Color fundus photograph.
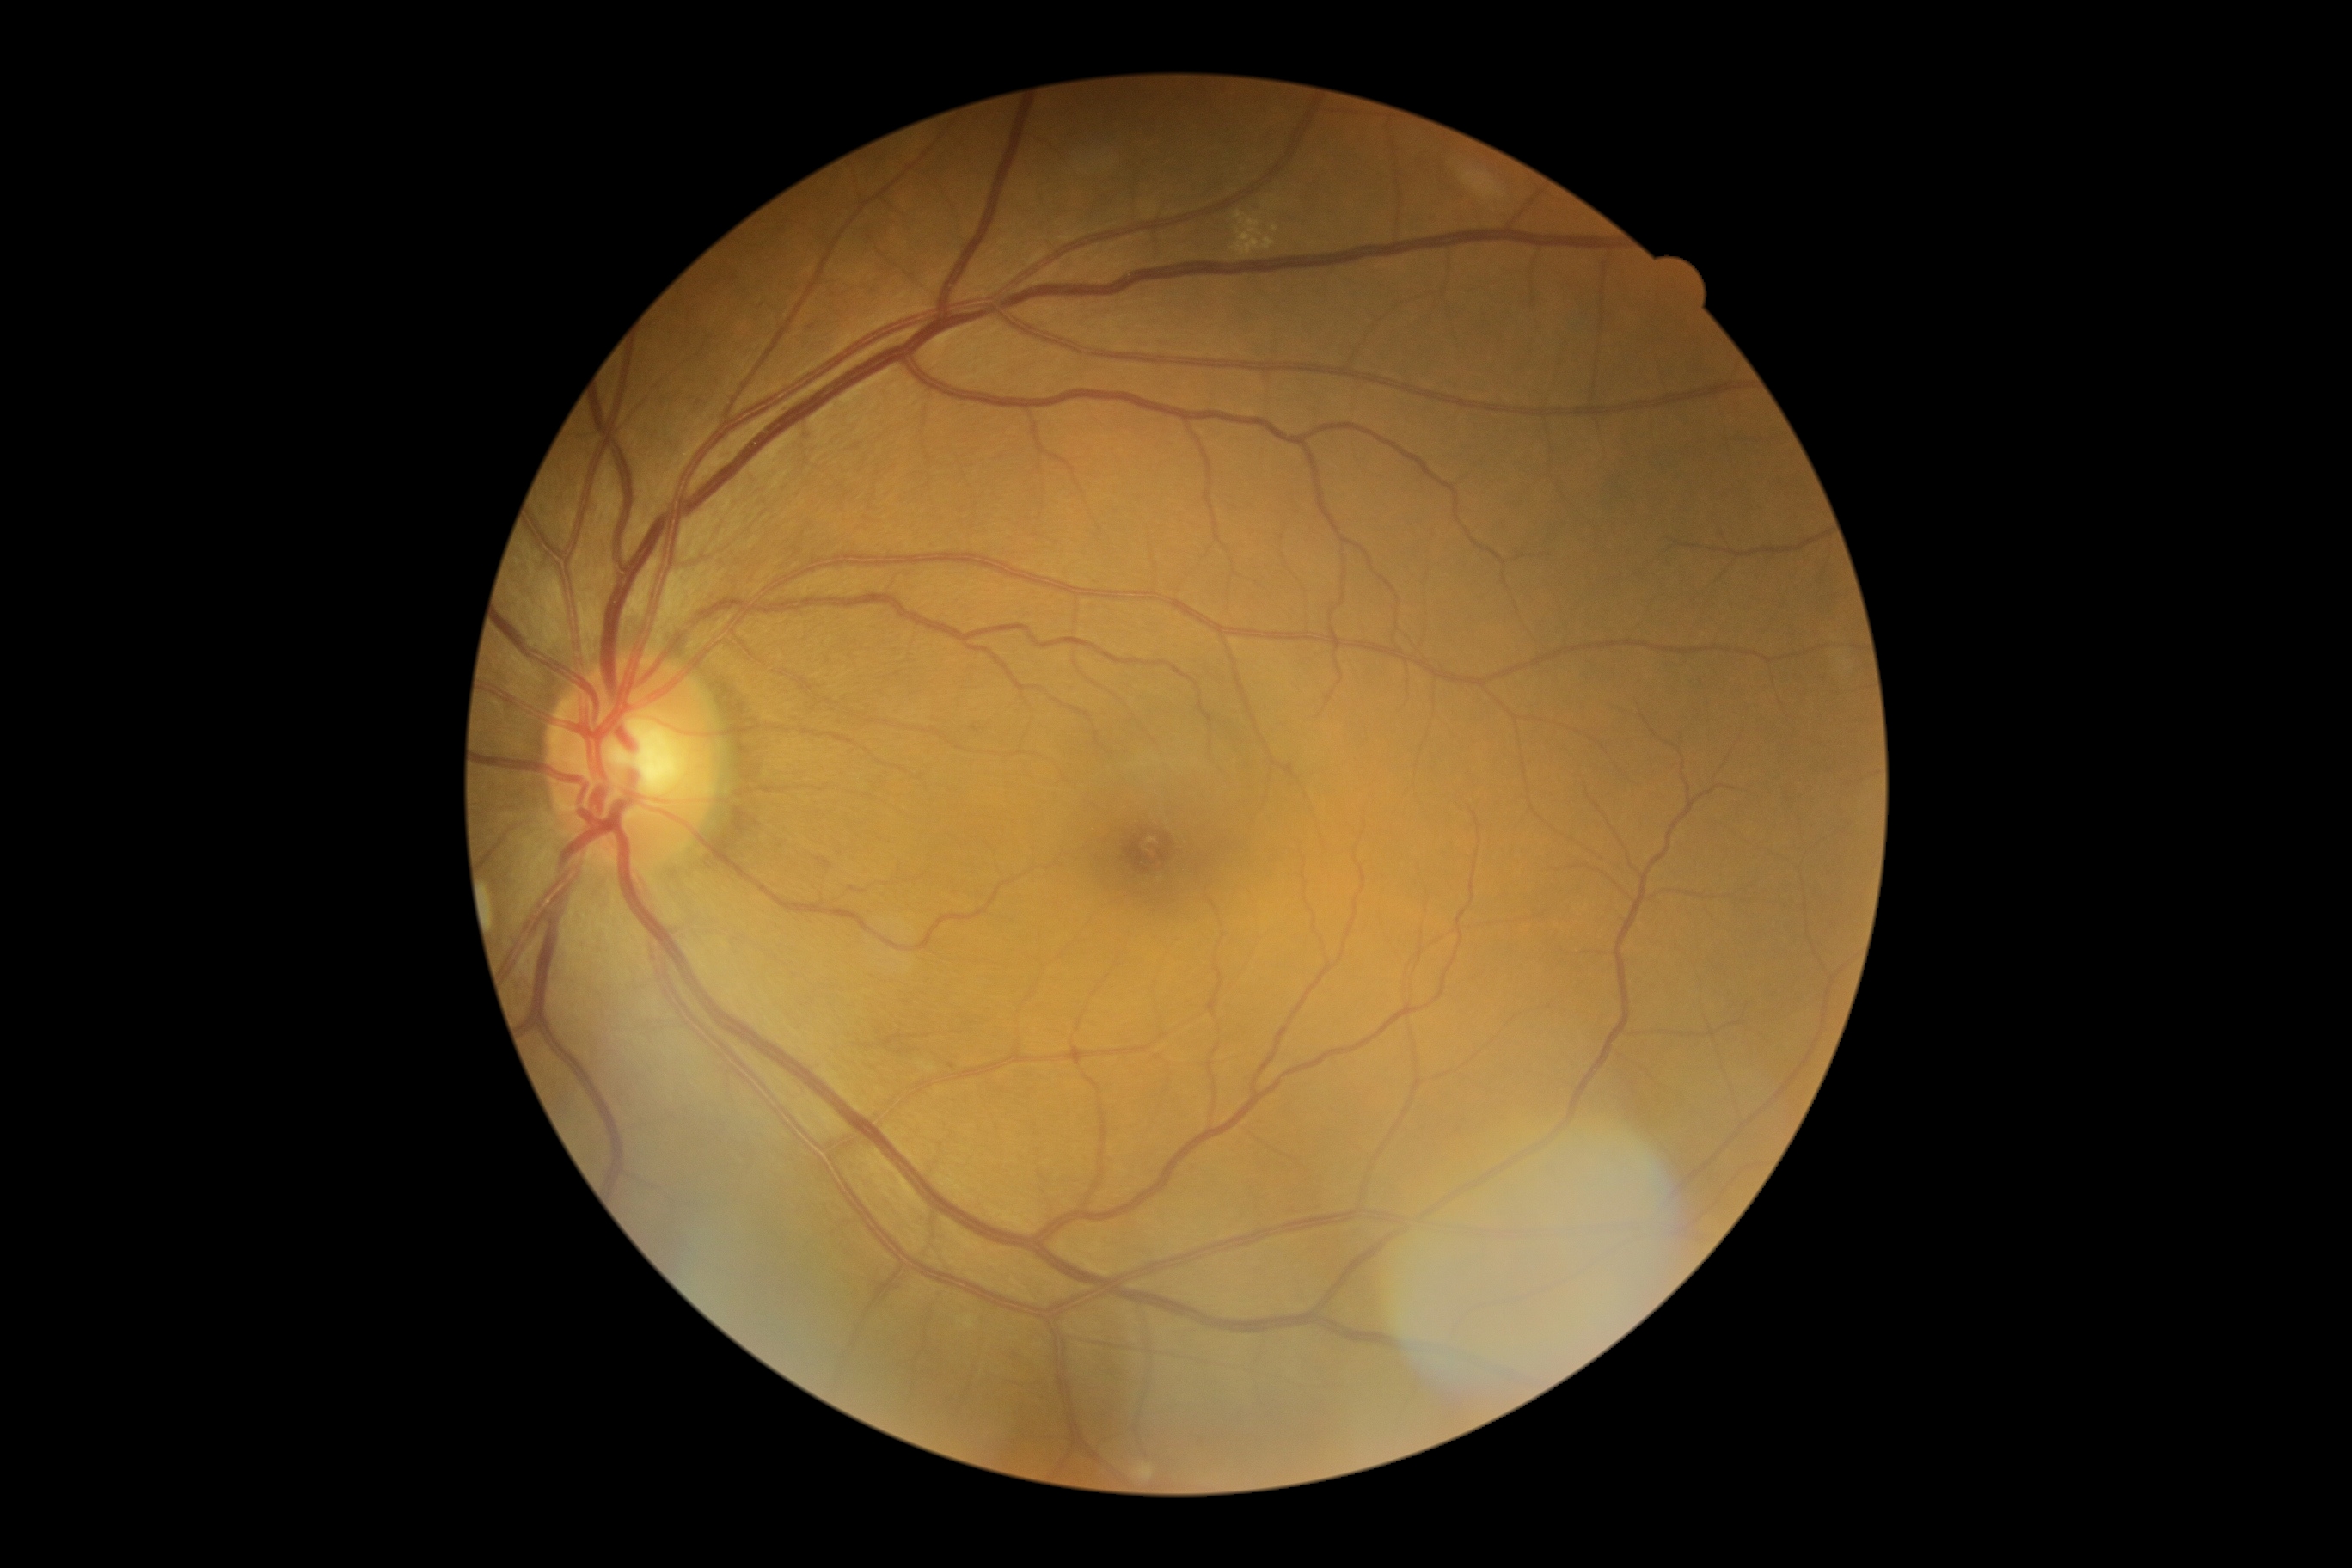 <lesions>
  <dr_grade>2</dr_grade>
  <he />
  <ma_small_centers>951/1066 | 811/327</ma_small_centers>
  <ex>(x1=1232, y1=211, x2=1277, y2=257)</ex>
  <ex_small_centers>1274/229</ex_small_centers>
  <se />
</lesions>